FOV: 45 degrees, 2352 by 1568 pixels, fundus photo — 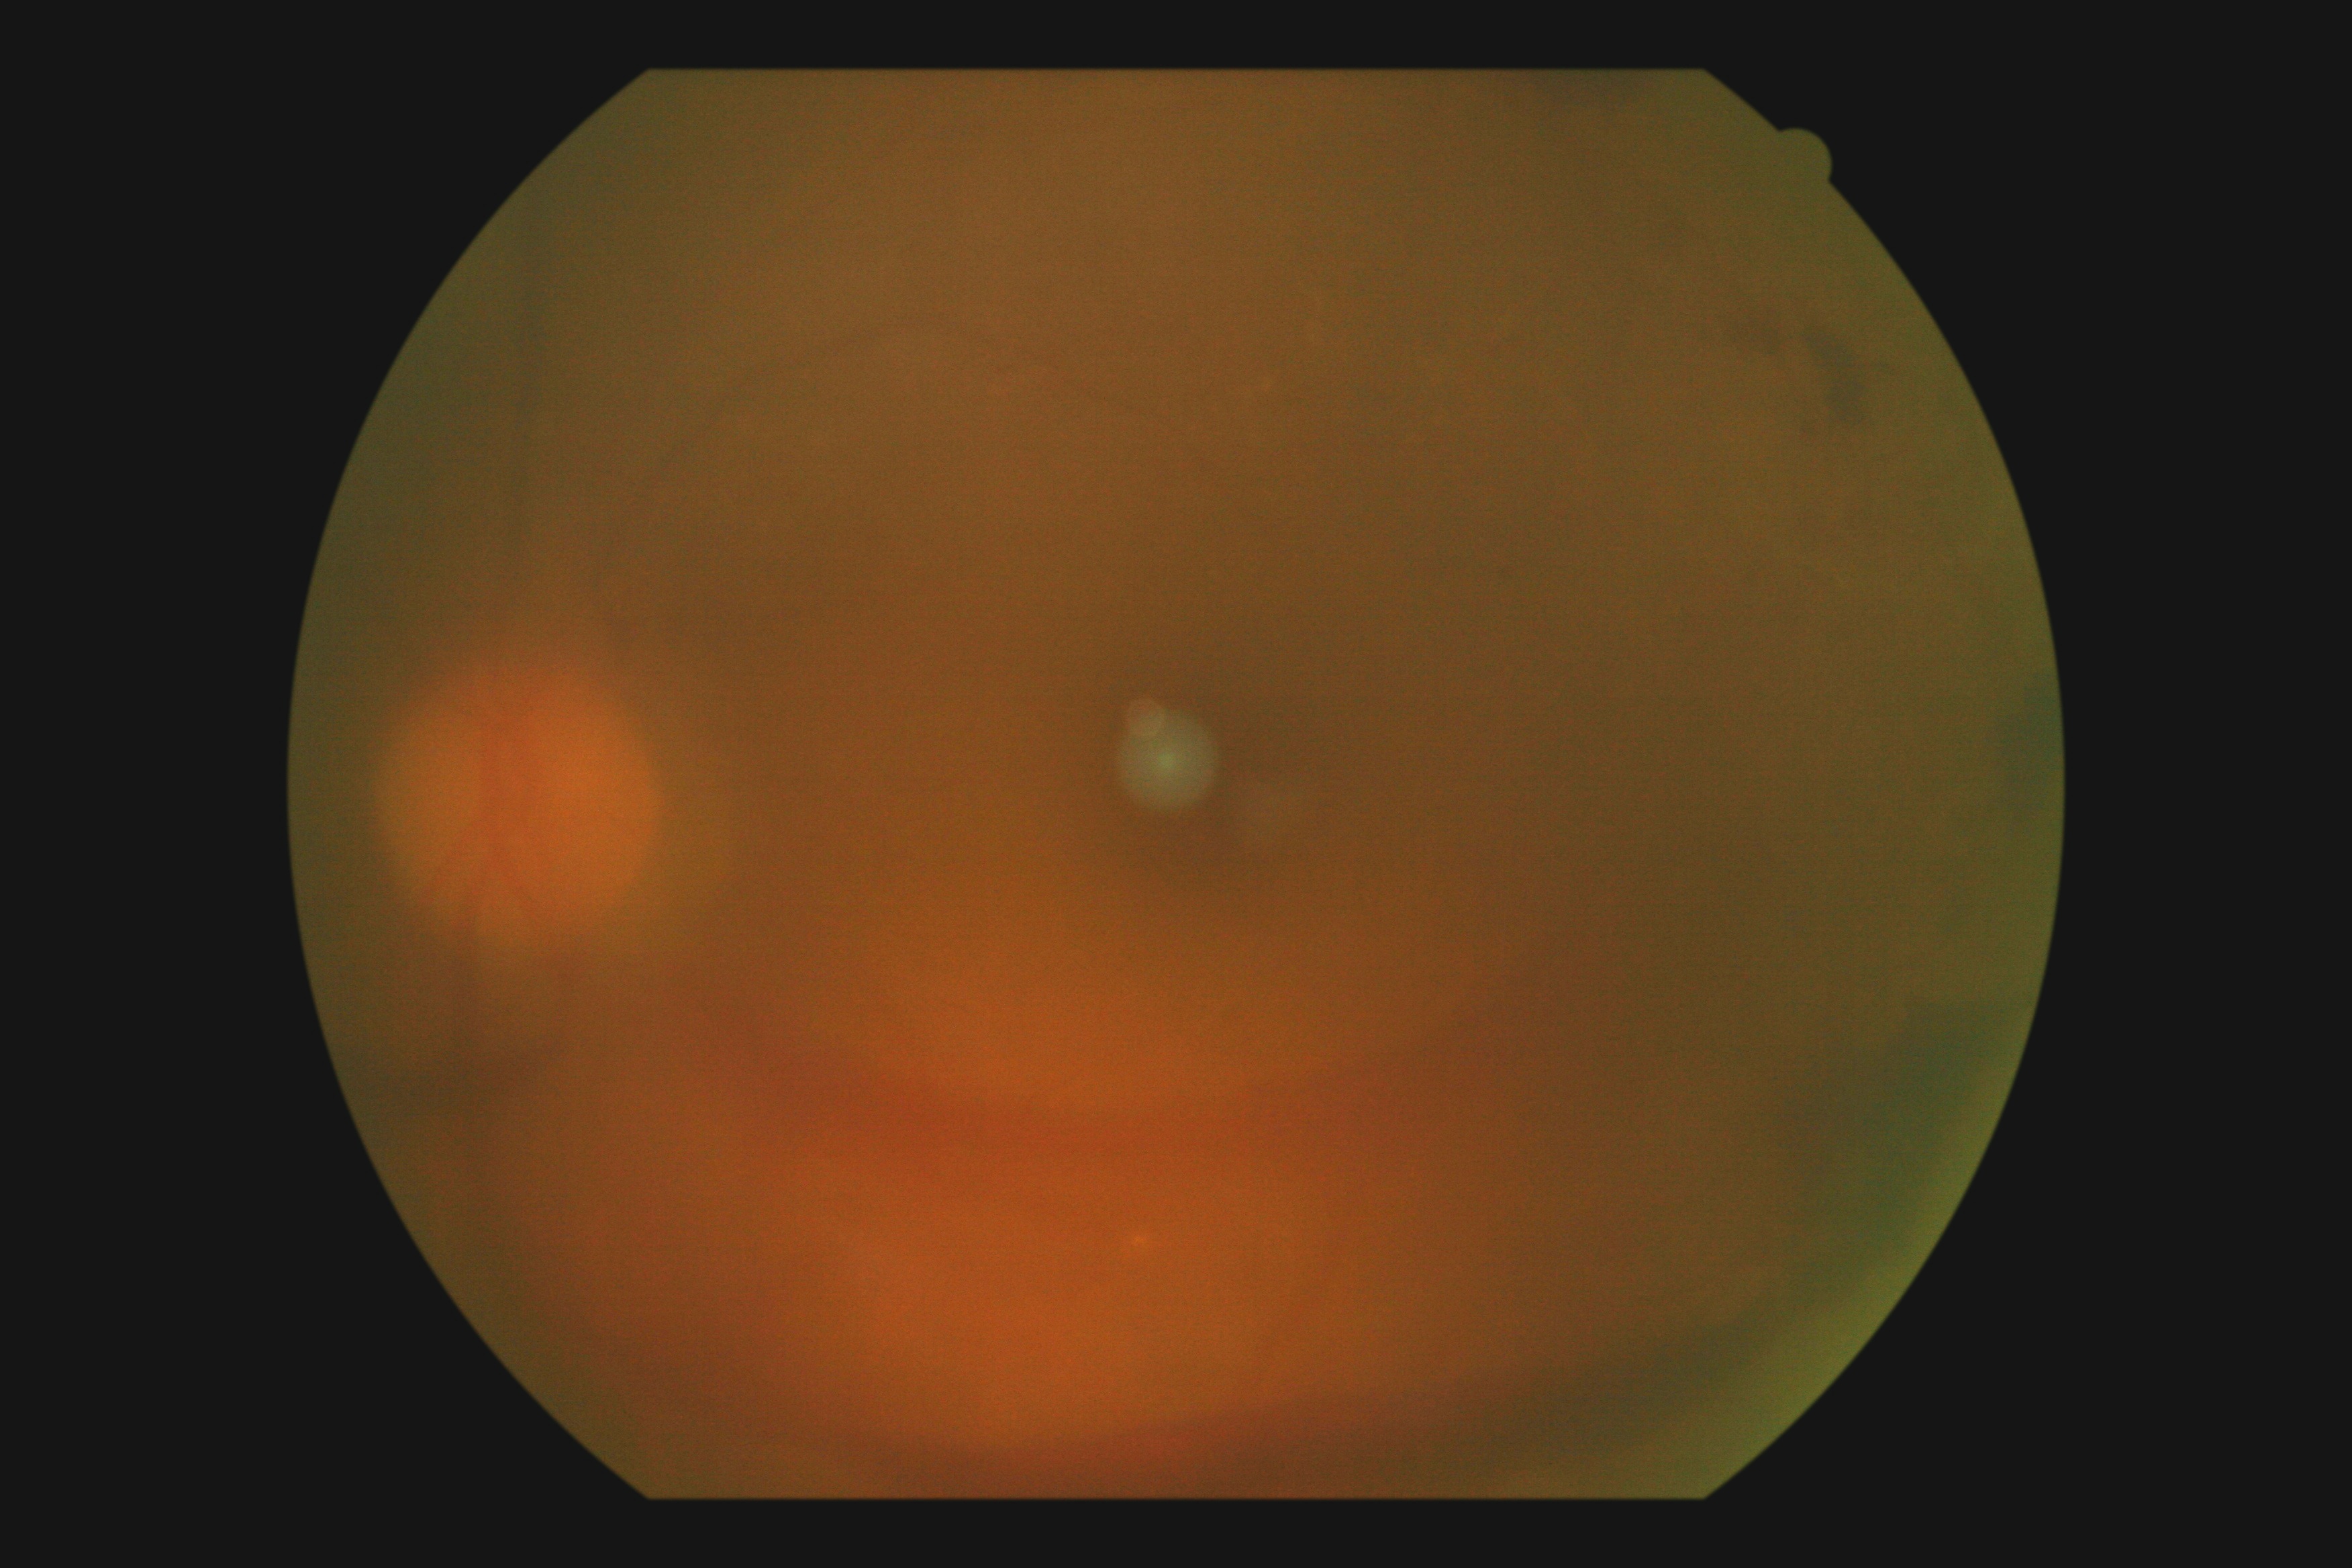 Diabetic retinopathy (DR): grade 4 (PDR).